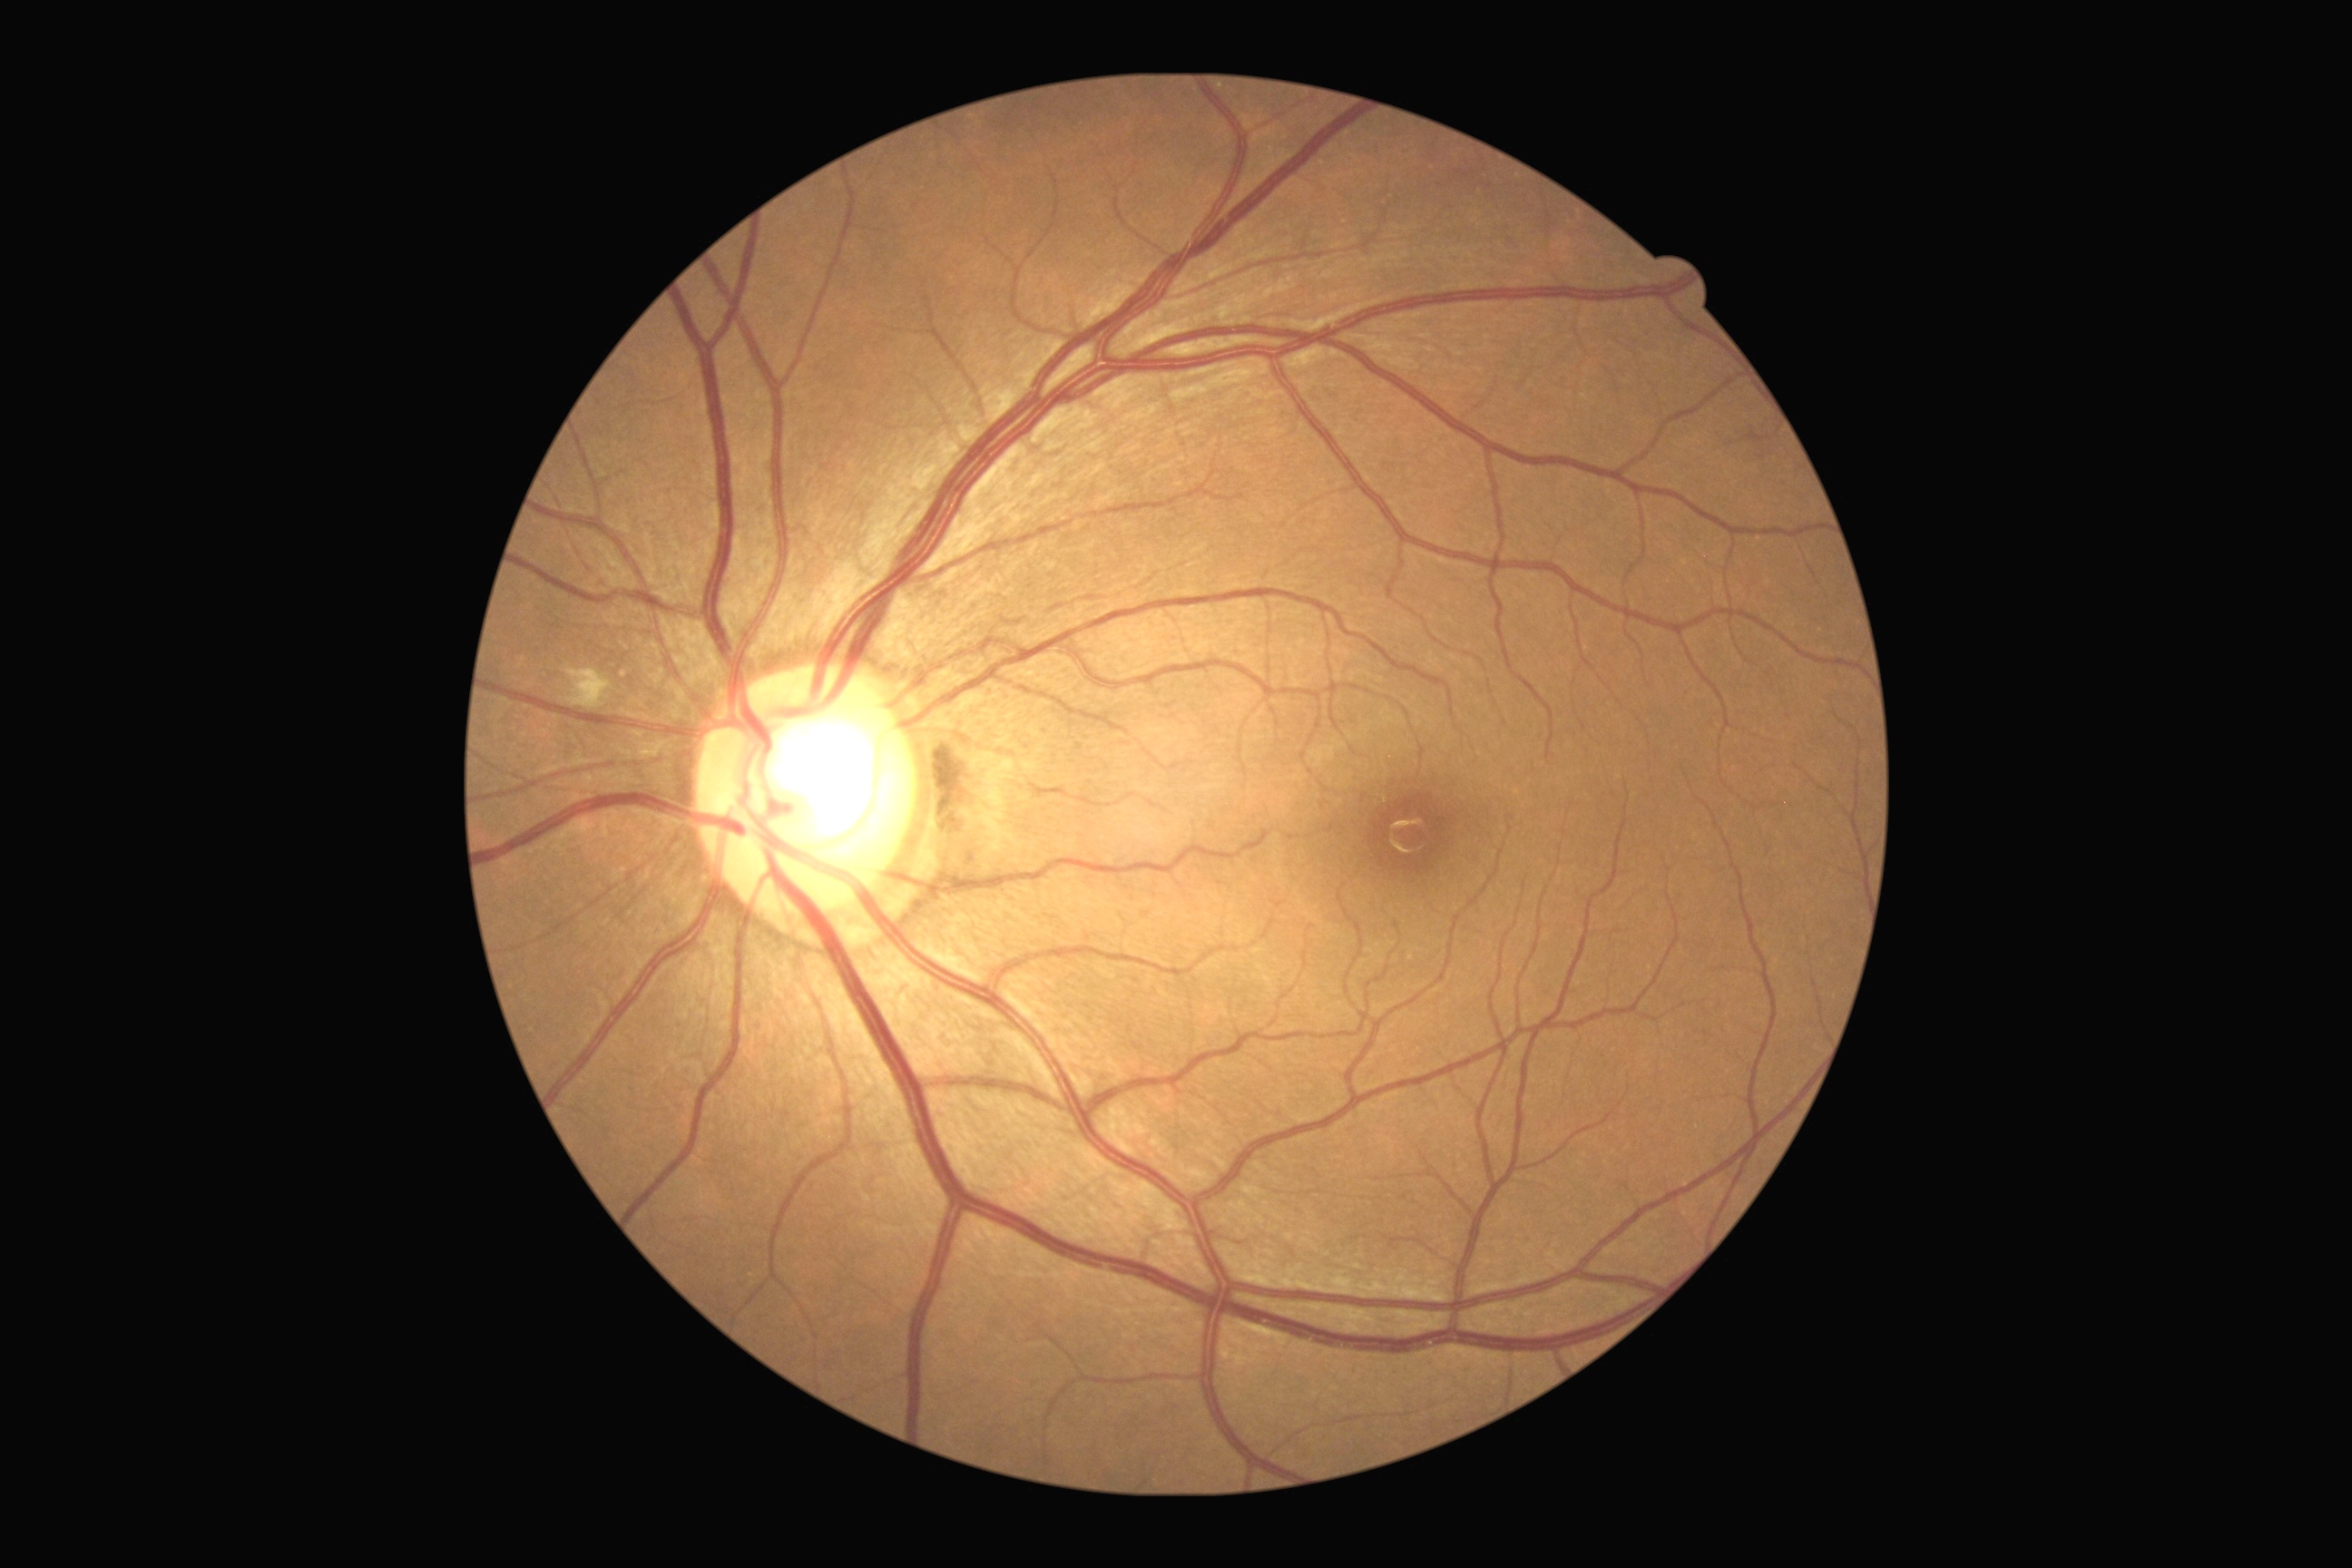
DR stage is moderate non-proliferative diabetic retinopathy (grade 2) — more than just microaneurysms but less than severe NPDR.